1240x1240; pediatric retinal photograph (wide-field); captured with the Phoenix ICON (100° field of view):
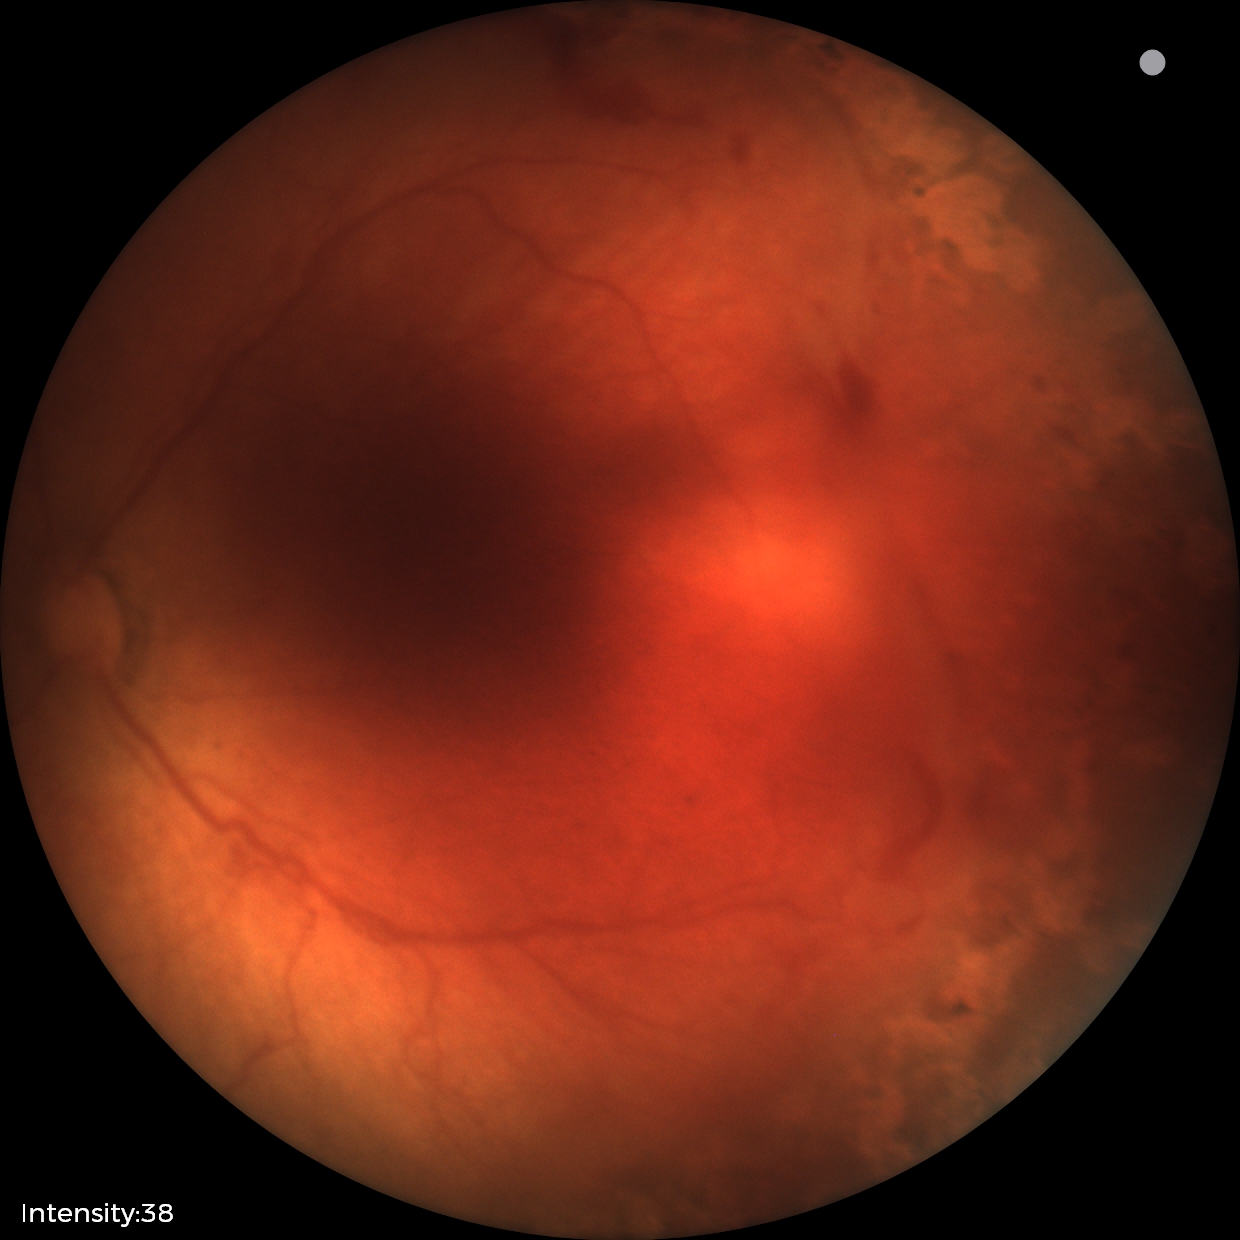
No plus disease. Diagnosis from this screening exam: status post retinopathy of prematurity (ROP).